Color fundus image, nonmydriatic fundus photograph.
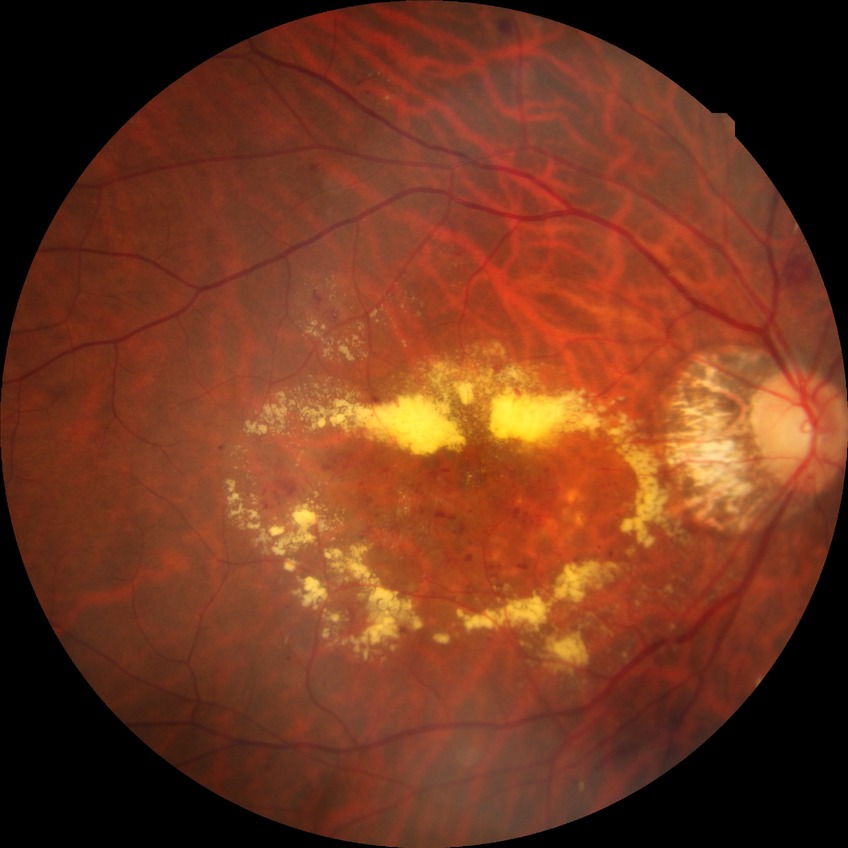 proliferative_class: non-proliferative diabetic retinopathy
davis_grade: simple diabetic retinopathy (SDR)